Pediatric retinal photograph (wide-field)
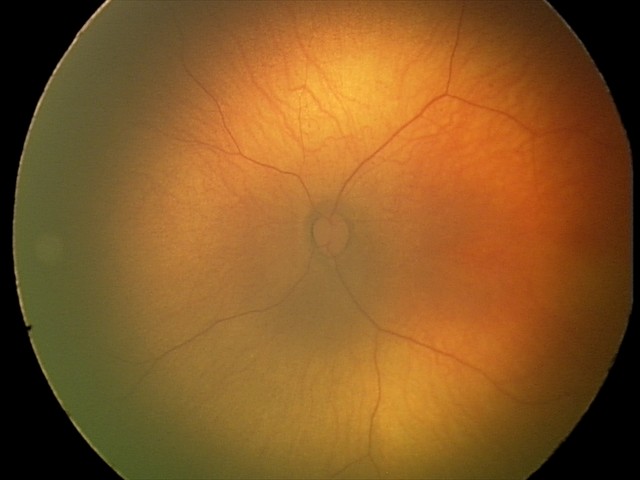

Normal screening examination.